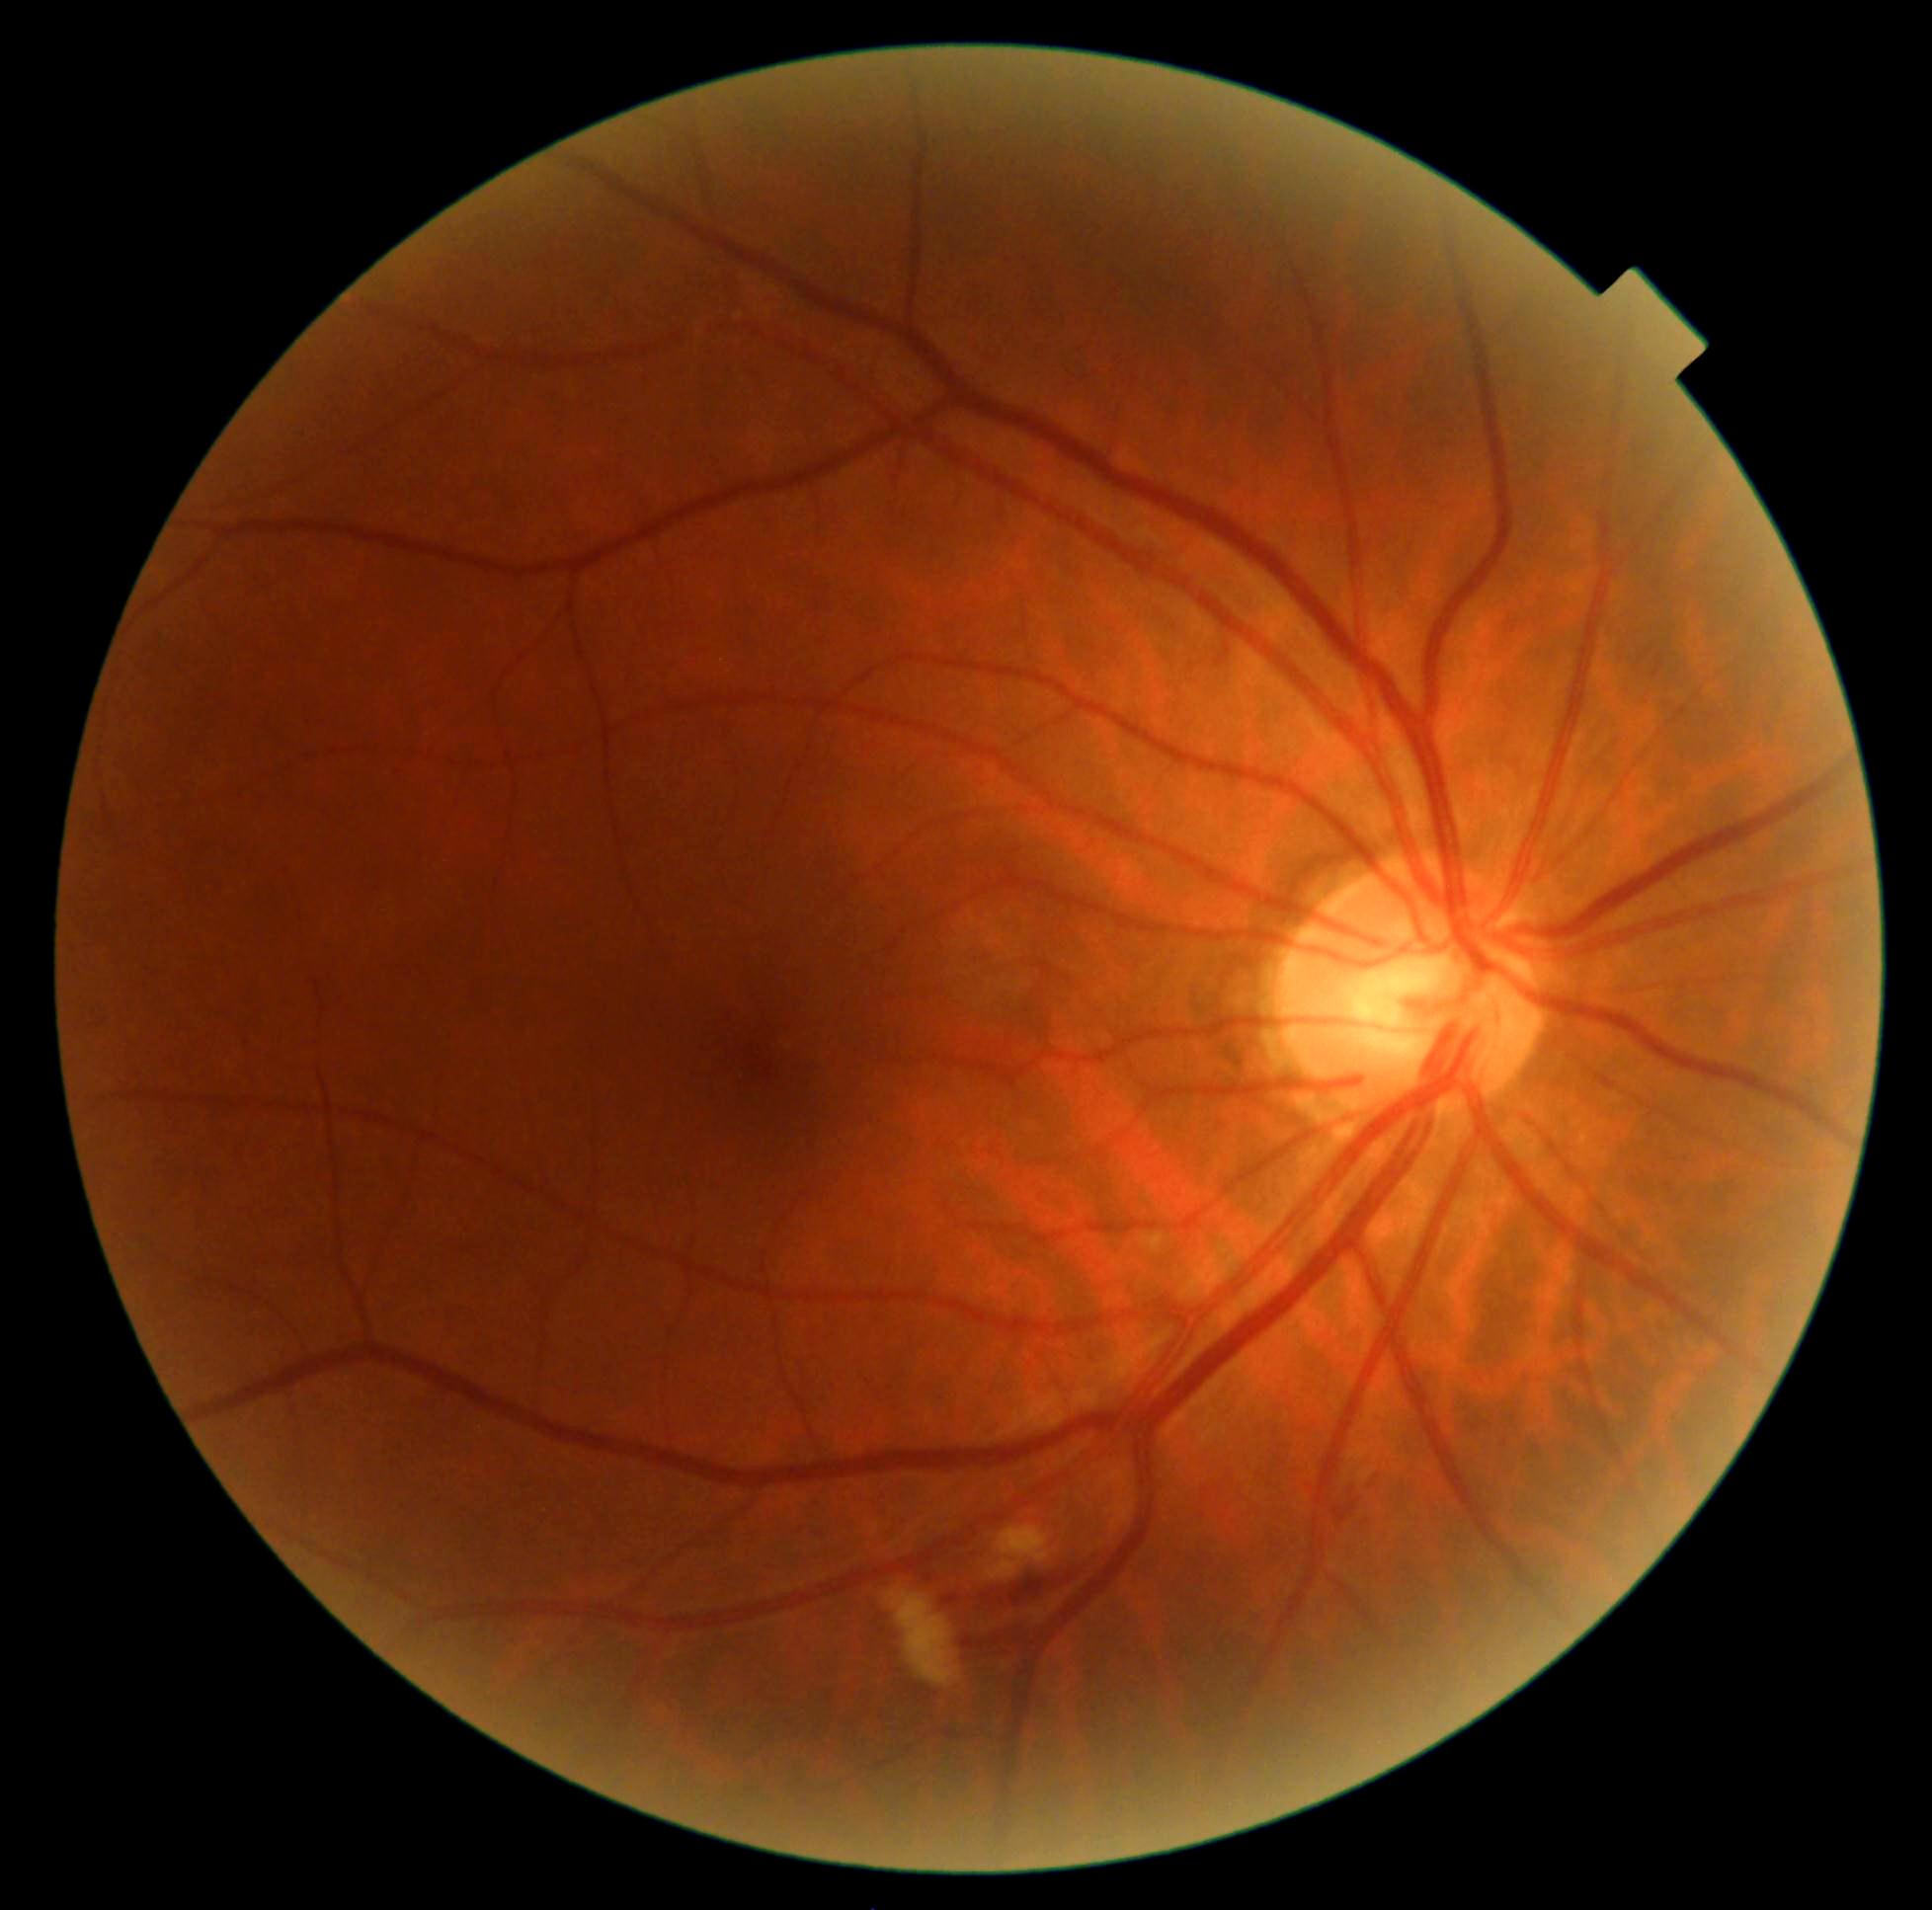
DR stage: 2 — more than just microaneurysms but less than severe NPDR.